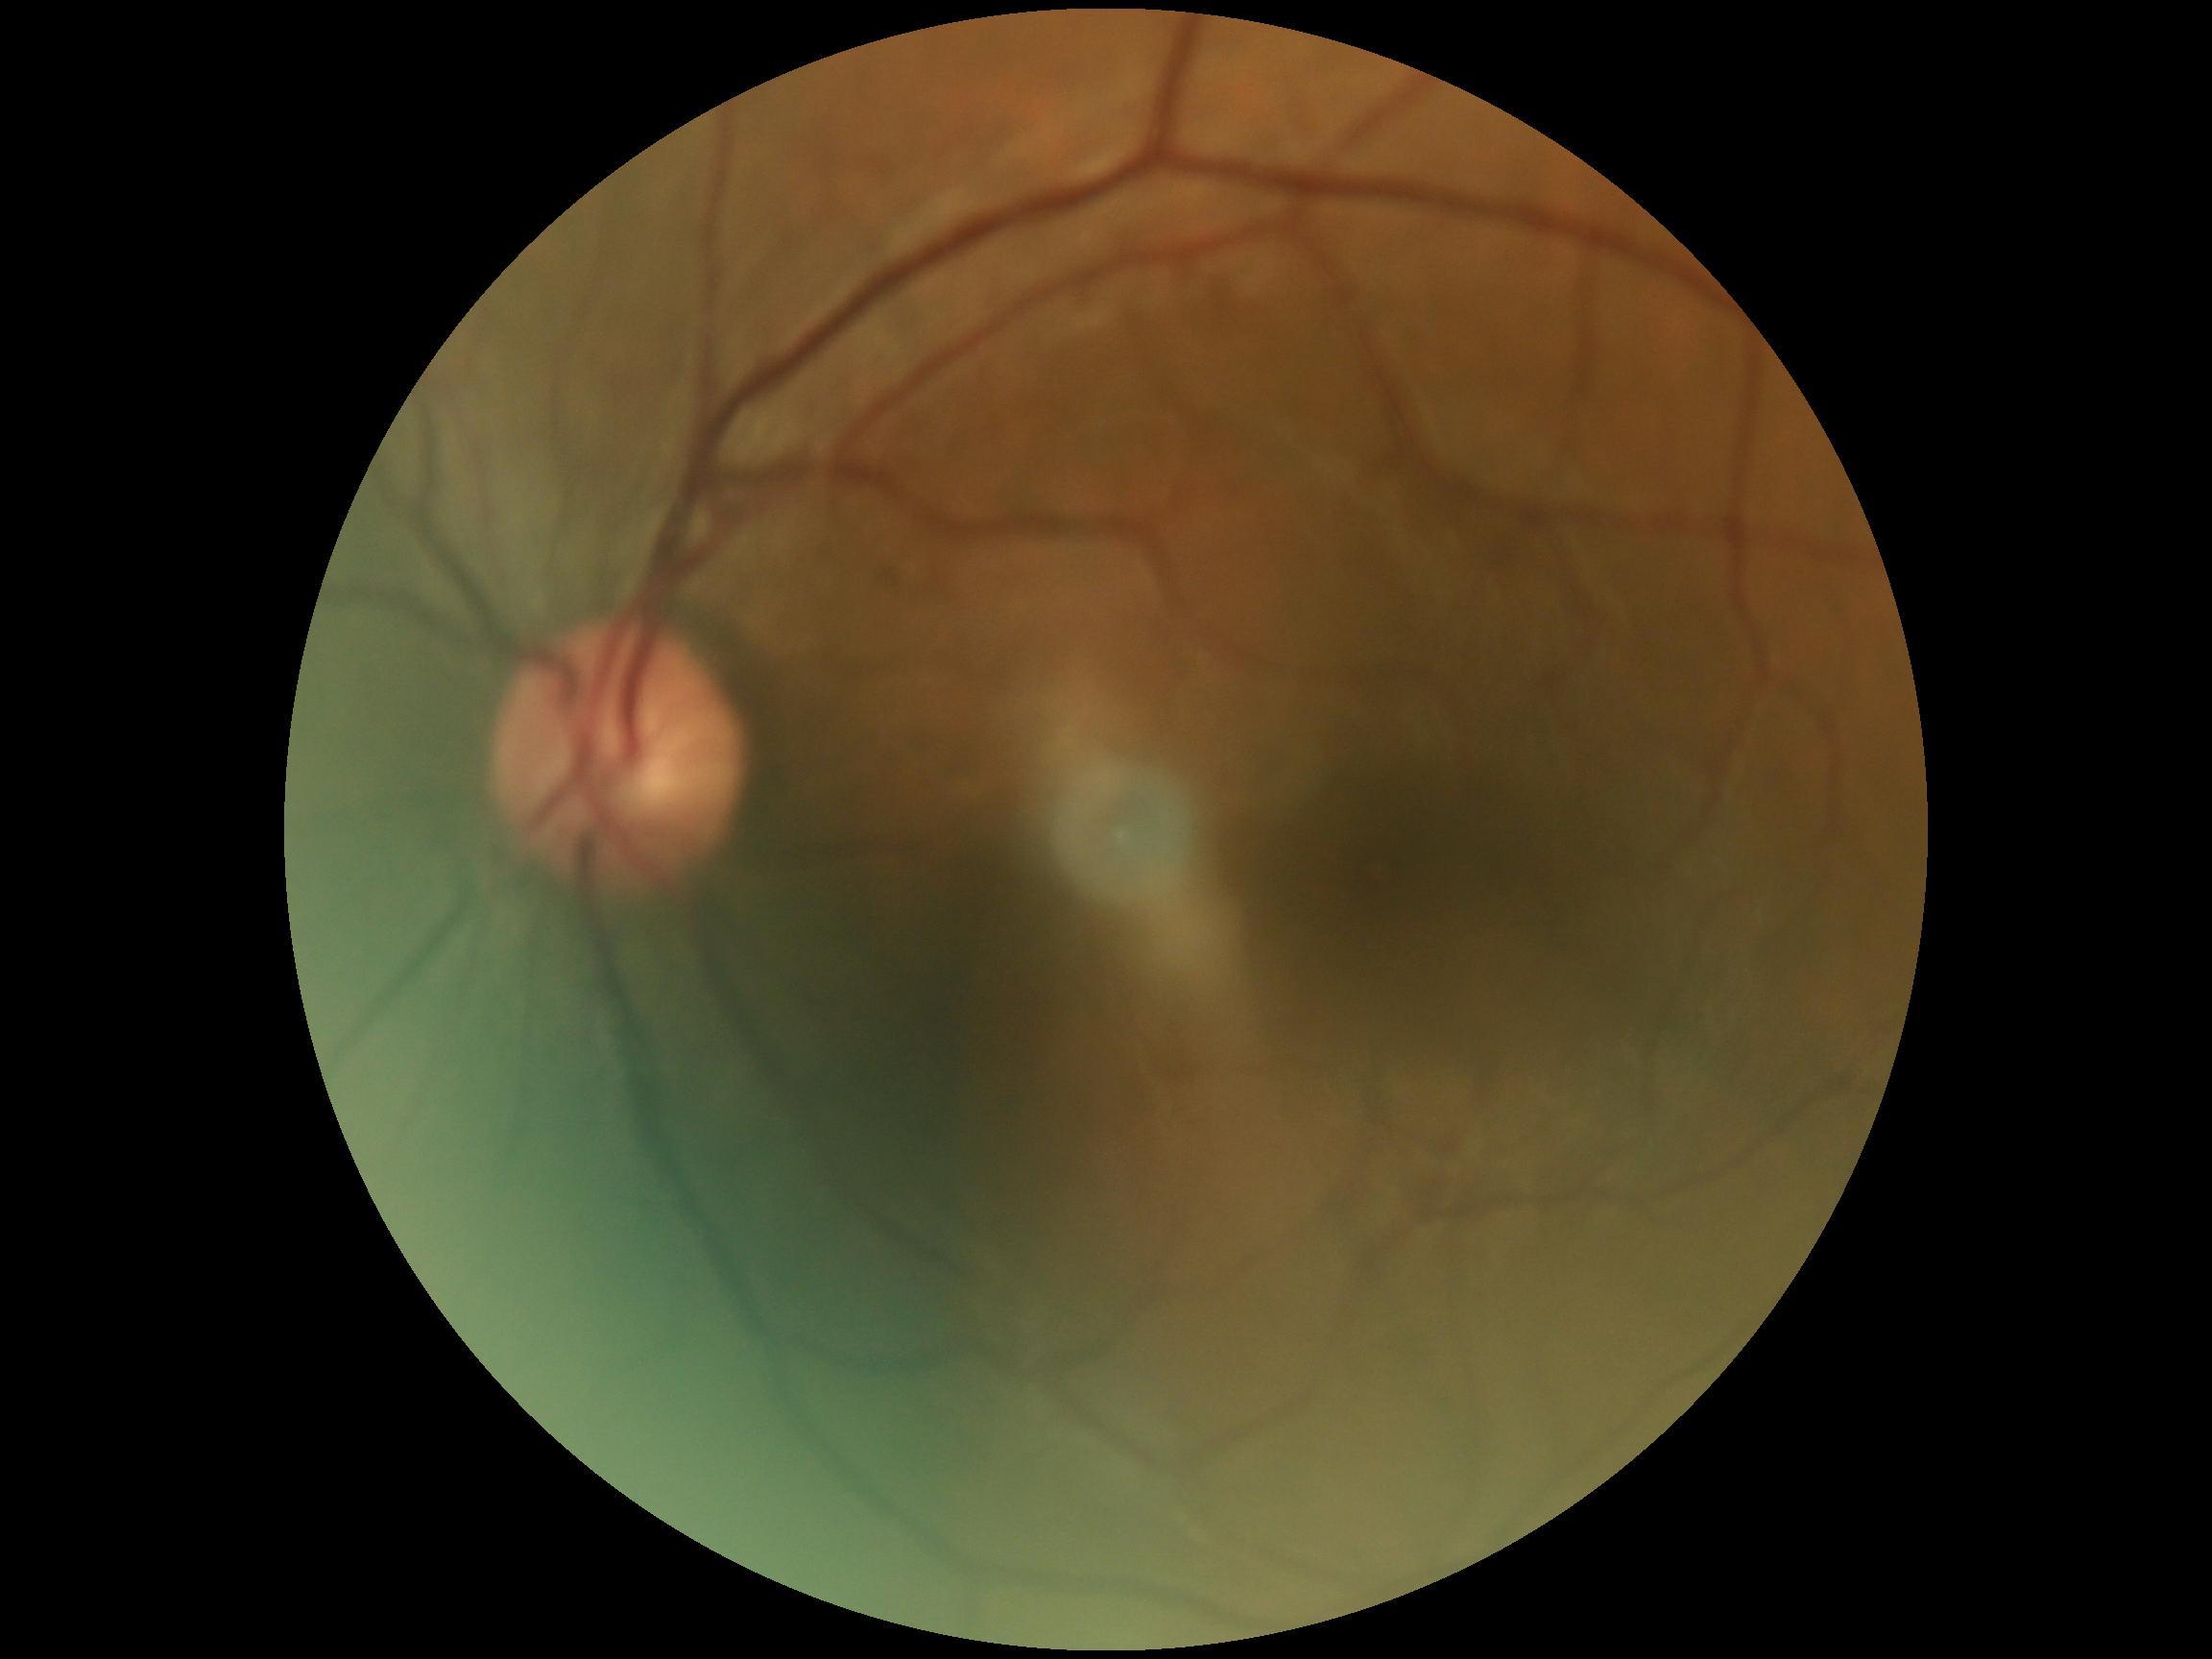
No diabetic retinal disease findings. Diabetic retinopathy (DR) is 0.